FOV: 45 degrees.
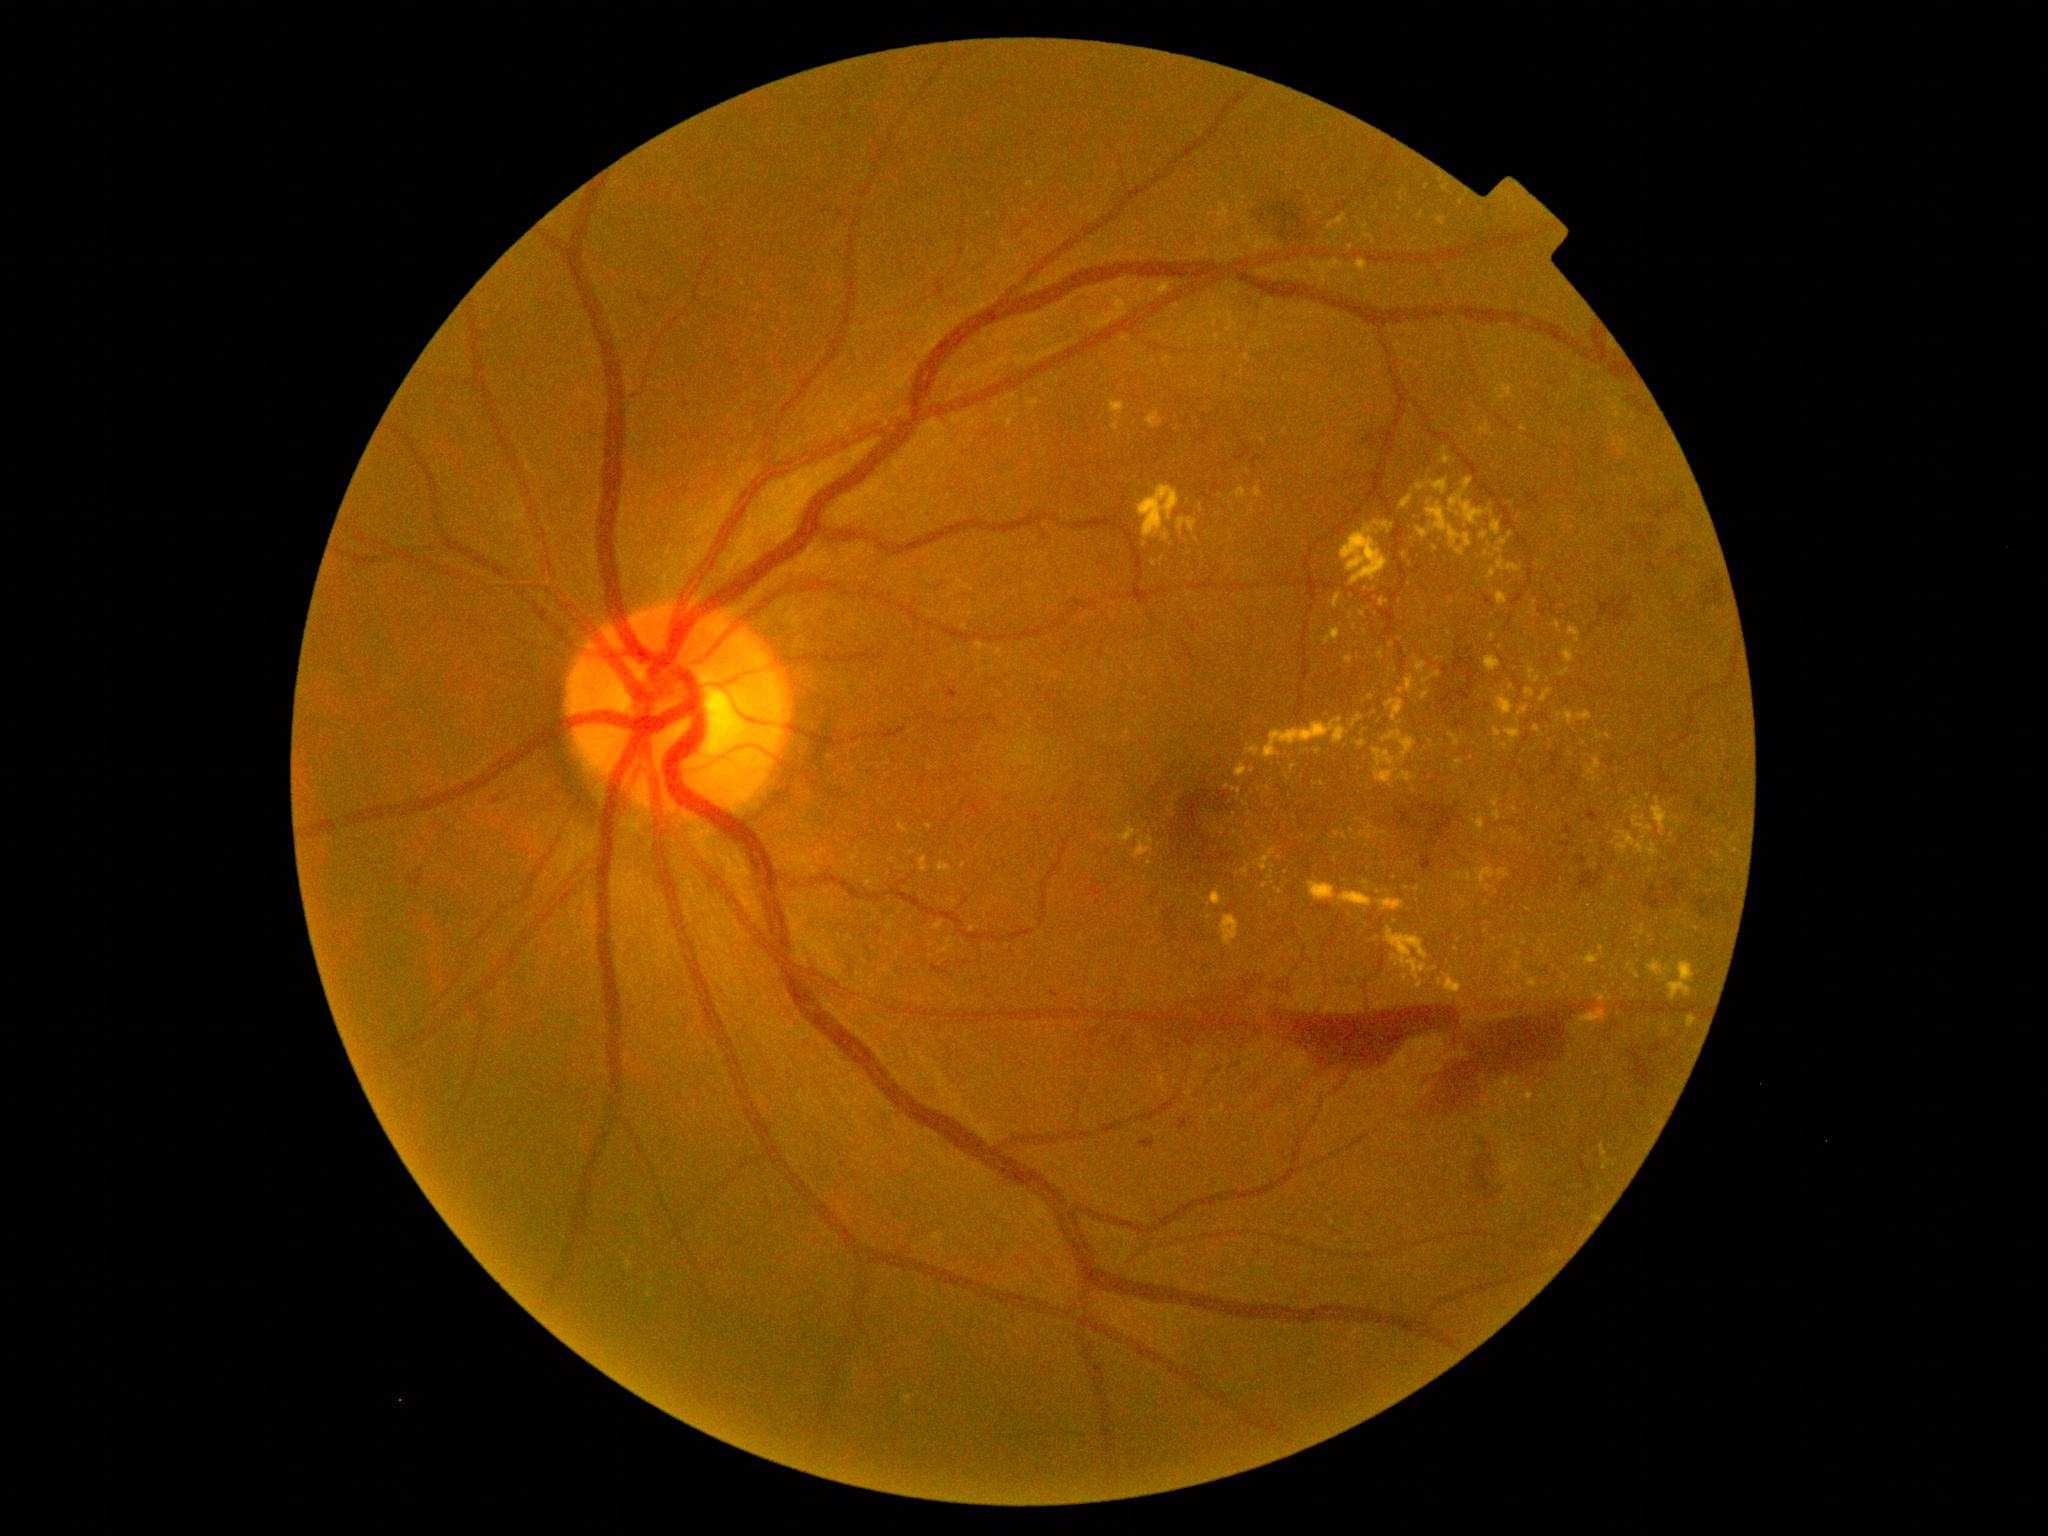
Diabetic retinopathy (DR) is 4. Hard exudates (EXs) (partial list) at 1456:548:1464:557; 1108:298:1126:321; 1467:873:1471:881; 1110:401:1125:414; 1398:772:1413:782; 1515:962:1520:971; 1526:1091:1534:1103; 1139:485:1181:540; 1417:484:1426:491; 1357:261:1368:272; 1178:518:1198:533. EXs (small, approximate centers) near <pt>1519,954</pt>; <pt>1719,857</pt>; <pt>1369,838</pt>; <pt>1392,645</pt>; <pt>1601,949</pt>; <pt>1511,535</pt>; <pt>1355,628</pt>; <pt>1594,780</pt>.